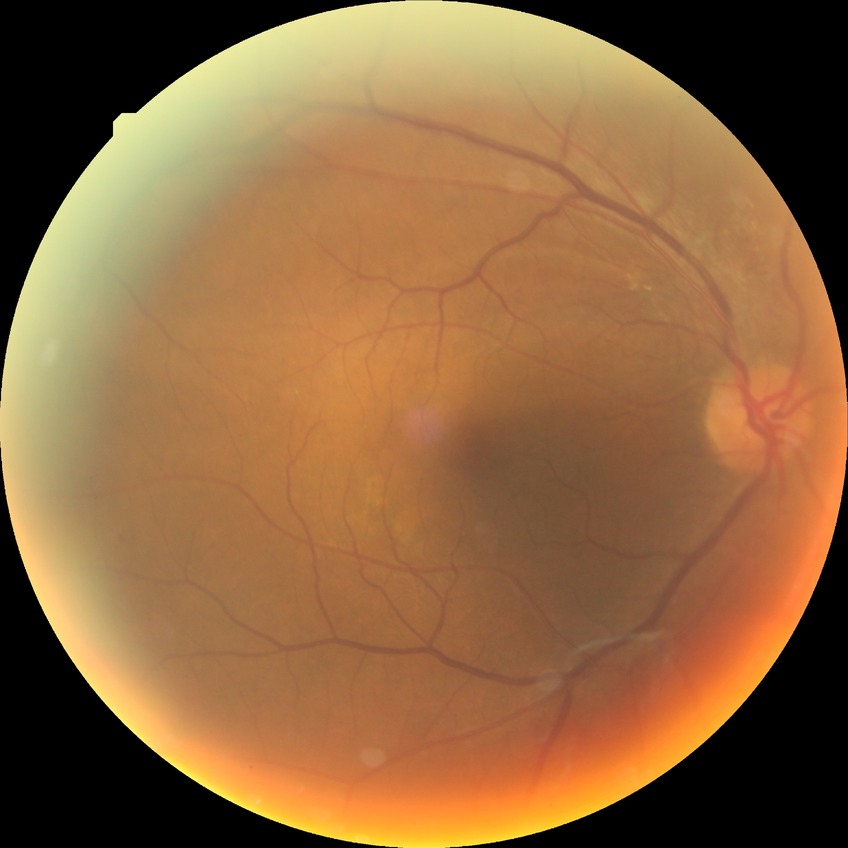 Davis grade: SDR.